UWF retinal mosaic: 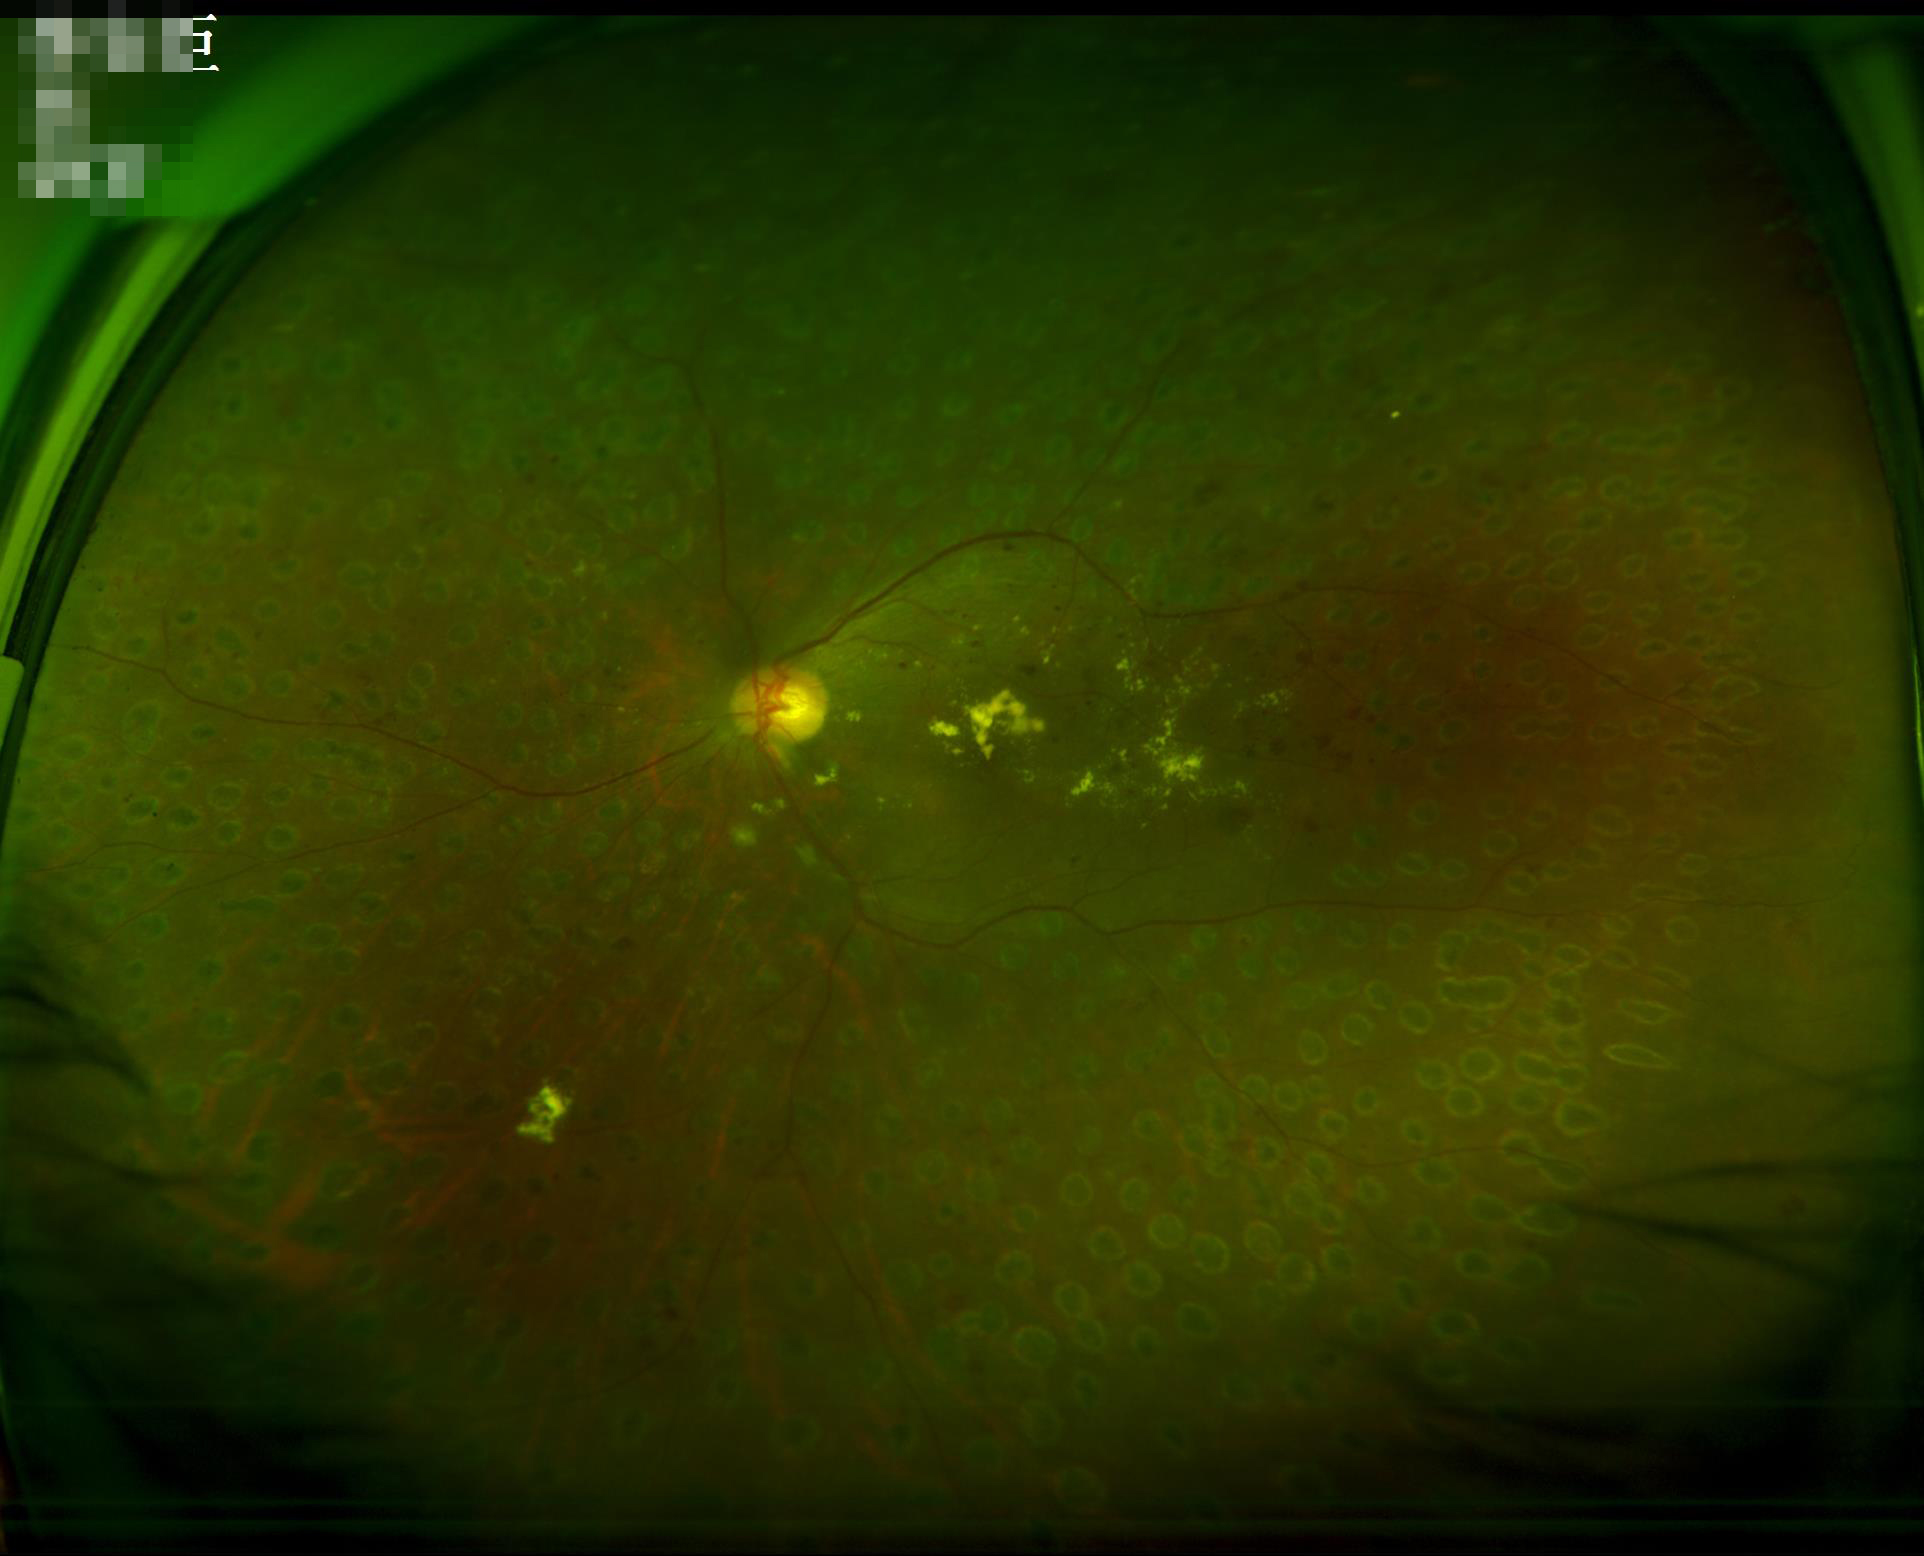
Vessels and details are hard to distinguish.
No over- or under-exposure.
Optic disc, vessels, and background are in focus.
Acceptable image quality.